Infant wide-field fundus photograph · captured with the Phoenix ICON (100° field of view) · 1240 by 1240 pixels.
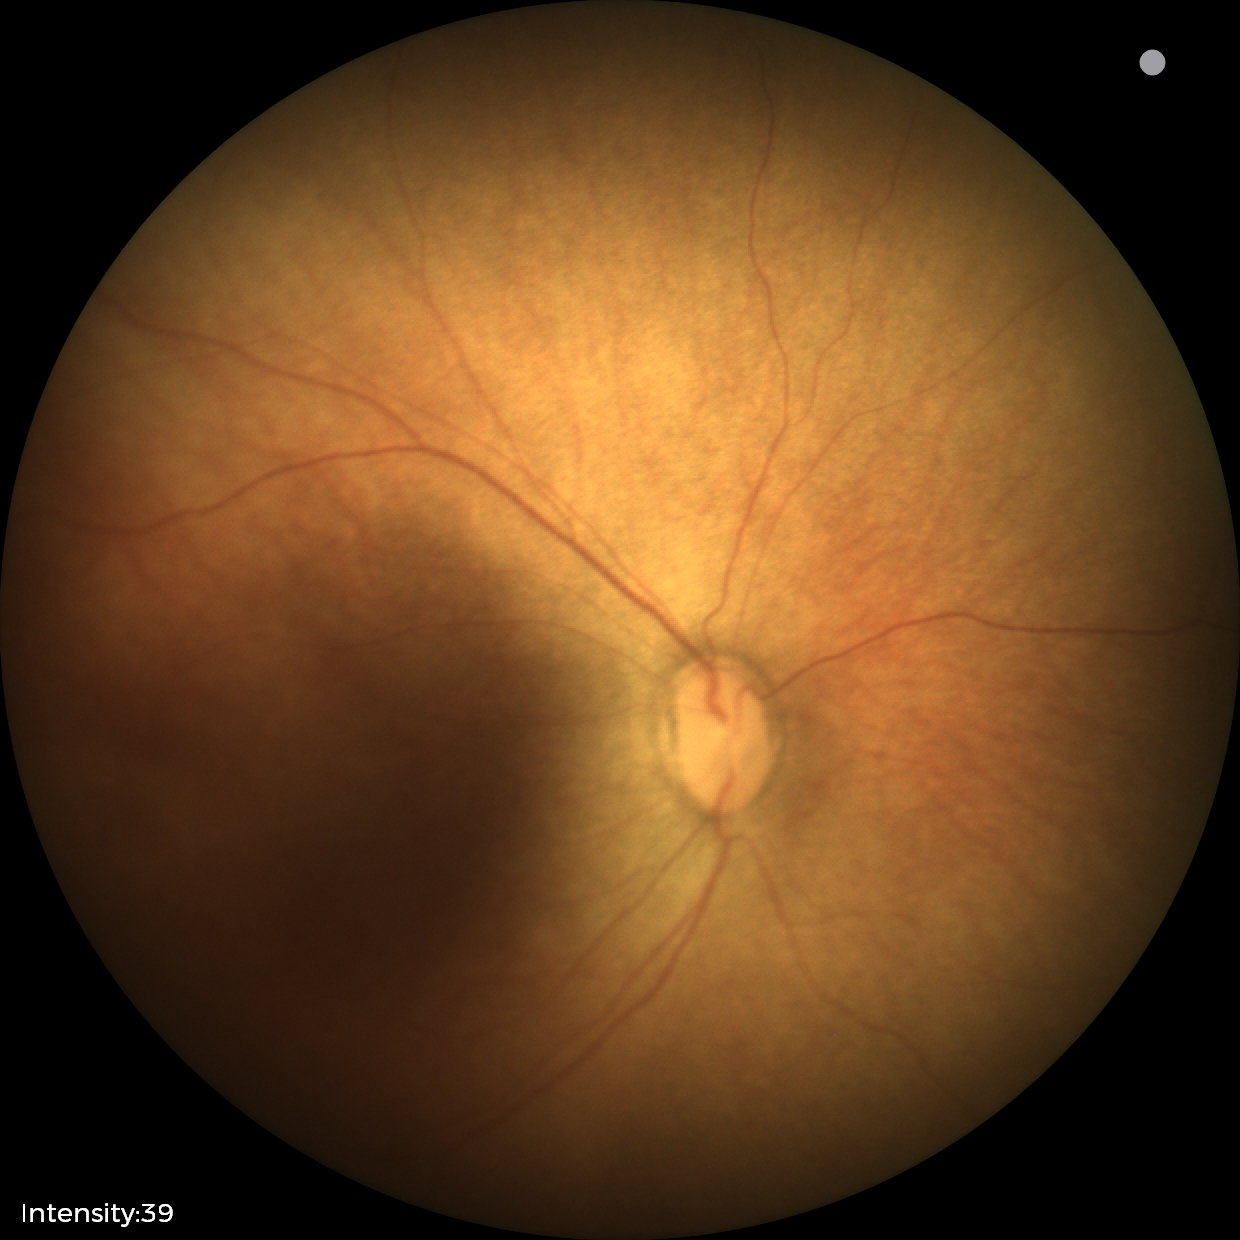 Normal screening examination.